Nonmydriatic fundus photograph · 848 x 848 pixels · CFP · 45-degree field of view
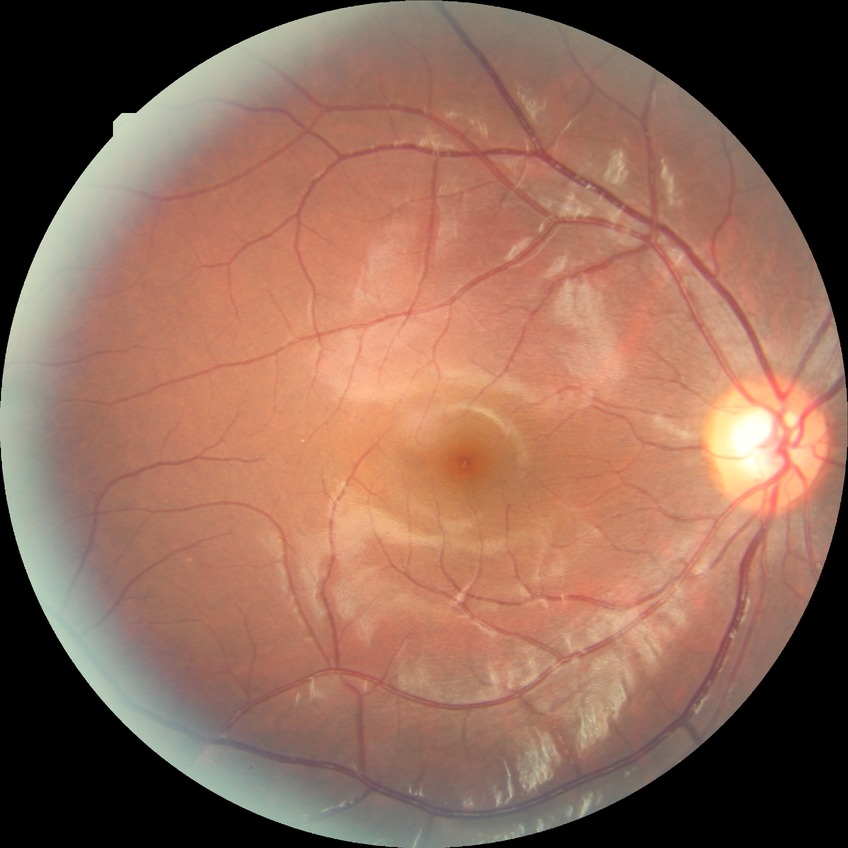
modified Davis grading = no diabetic retinopathy.